Graded on the modified Davis scale.
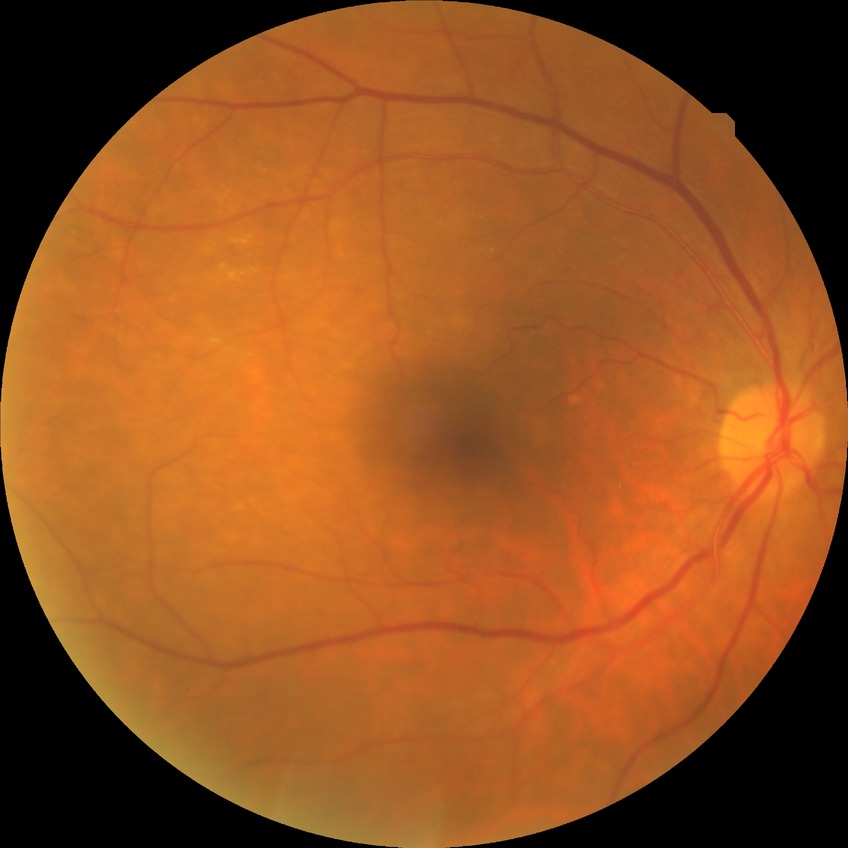 {
  "davis_grade": "simple diabetic retinopathy"
}